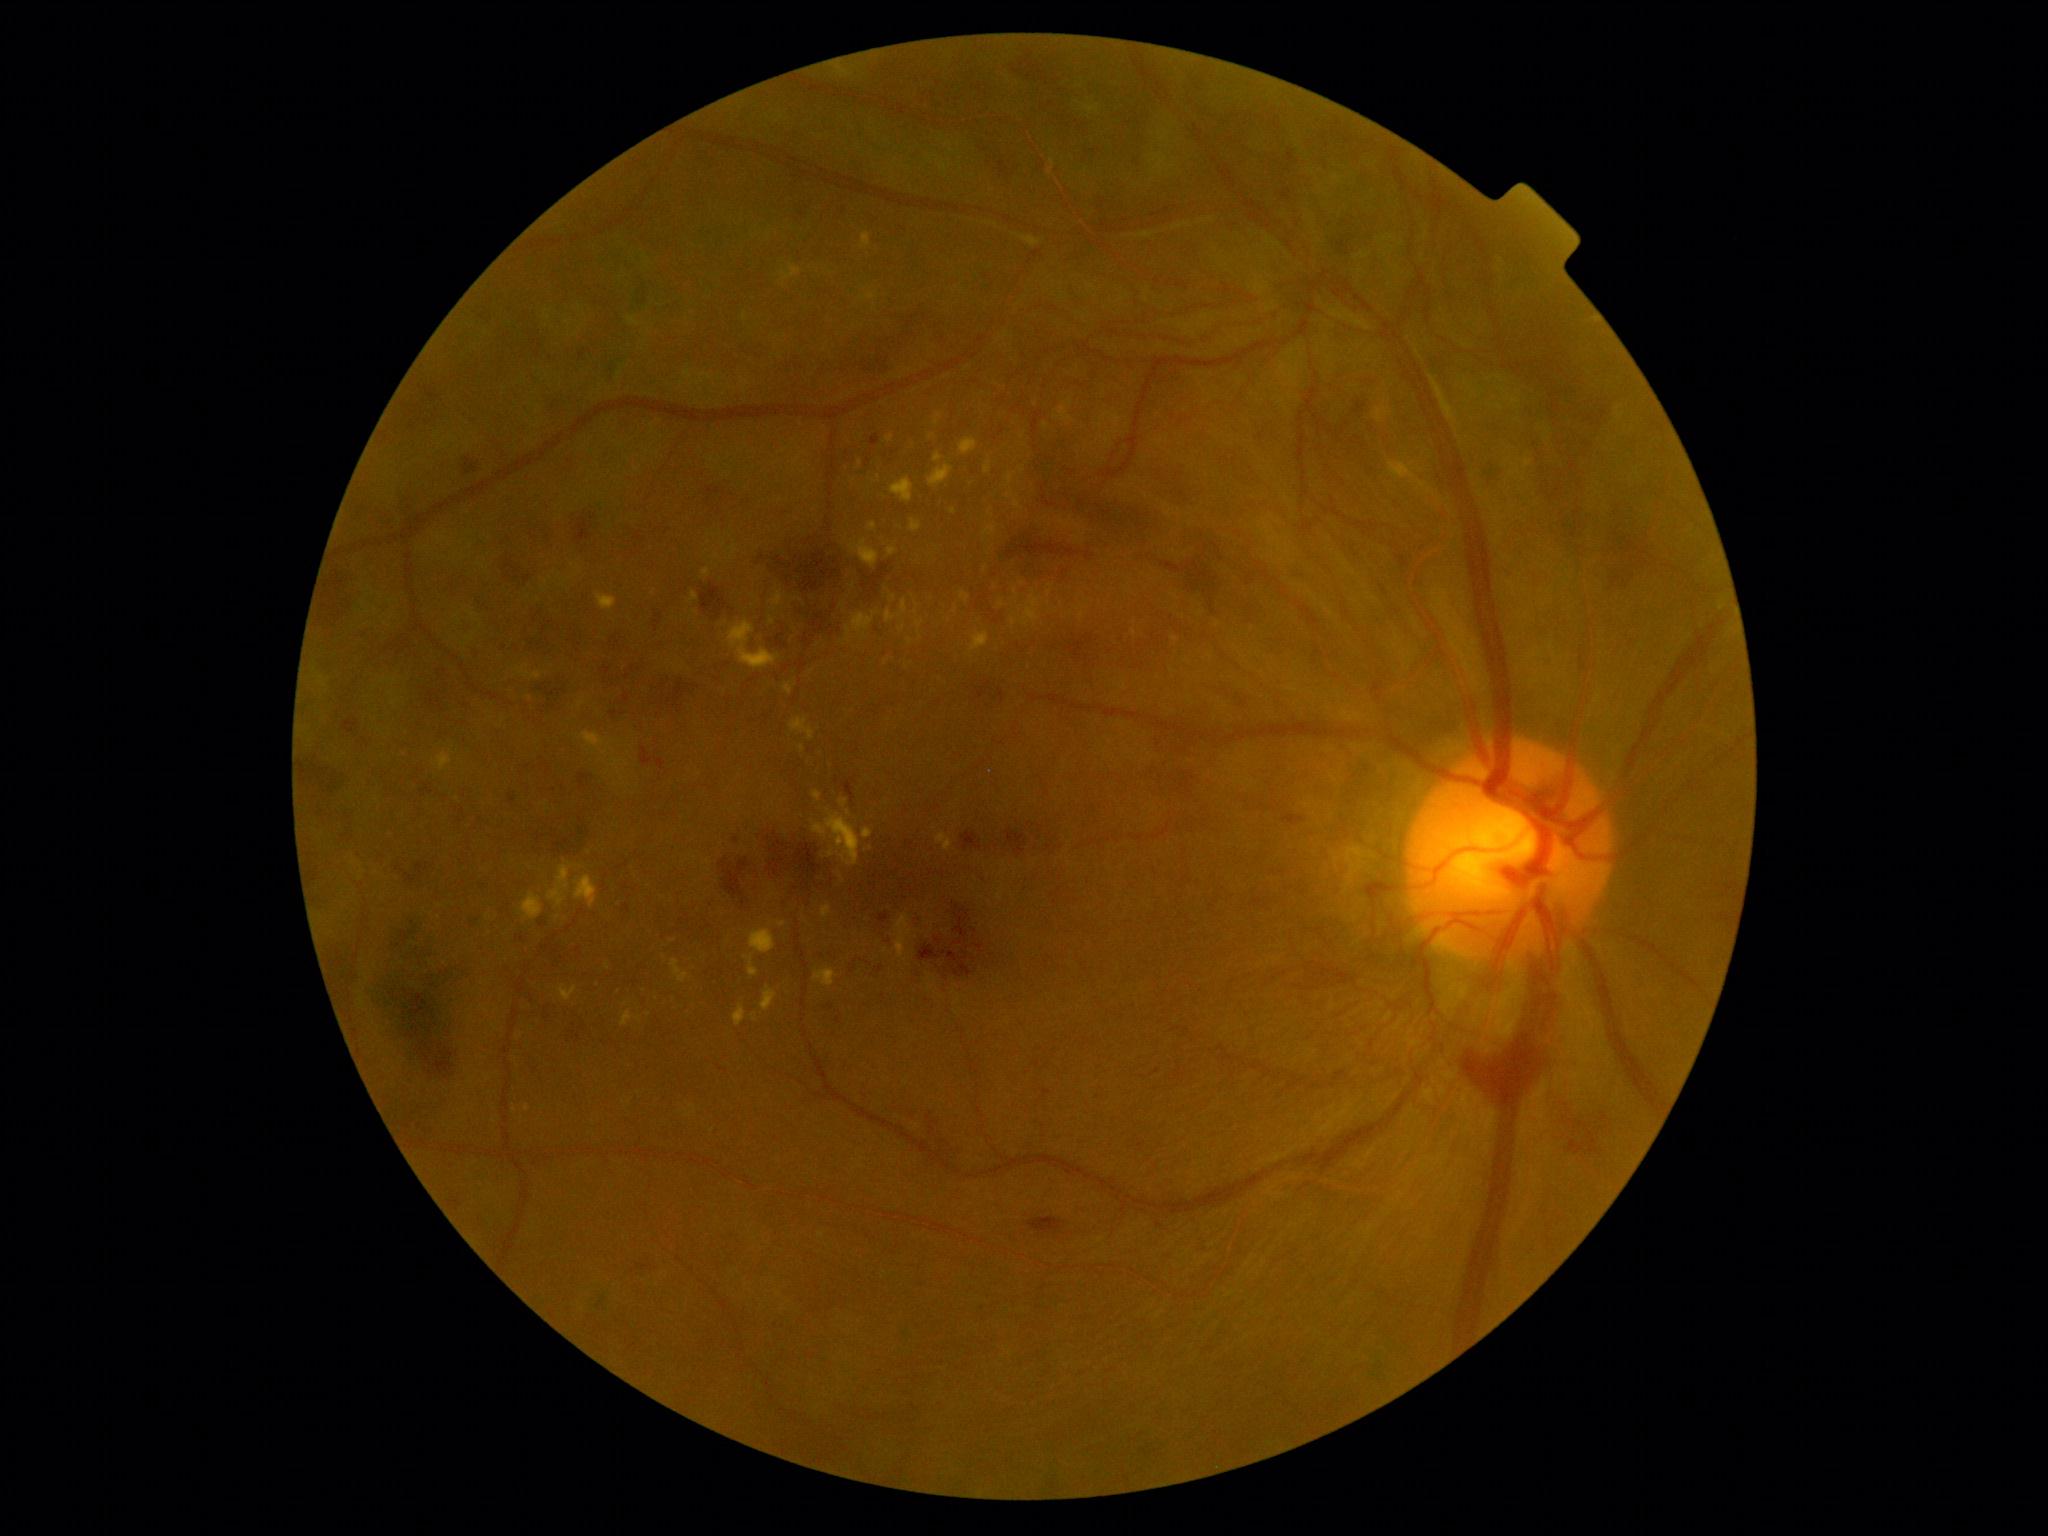

DR stage is PDR (grade 4). EXs are present, including at <box>929,464,953,488</box>, <box>961,591,971,603</box>, <box>1101,412,1121,425</box>, <box>1171,594,1180,600</box>, <box>1054,403,1074,422</box>, <box>895,915,913,959</box>, <box>839,799,849,809</box>, <box>688,591,700,604</box>, <box>959,438,978,455</box>, <box>1011,617,1018,627</box>, <box>916,621,925,630</box>. Small EXs approximately at {"x": 843, "y": 880}, {"x": 1049, "y": 594}, {"x": 860, "y": 464}, {"x": 527, "y": 1108}, {"x": 772, "y": 886}, {"x": 885, "y": 950}, {"x": 1174, "y": 639}, {"x": 363, "y": 872}.